FOV: 45 degrees:
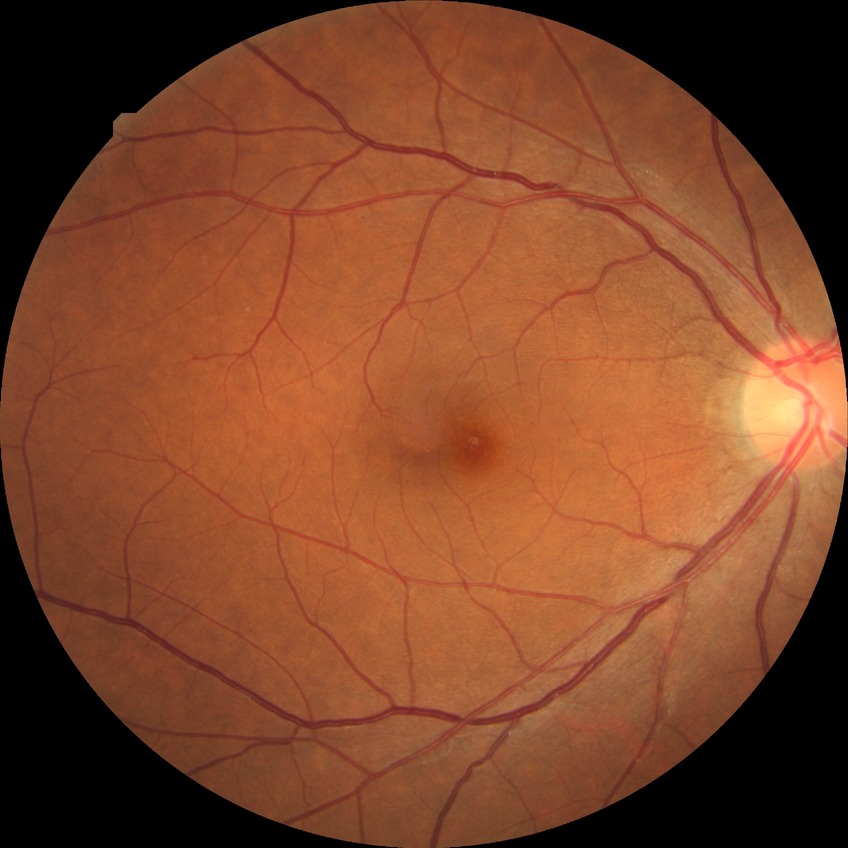 Diabetic retinopathy (DR) is NDR (no diabetic retinopathy).